Color fundus photograph.
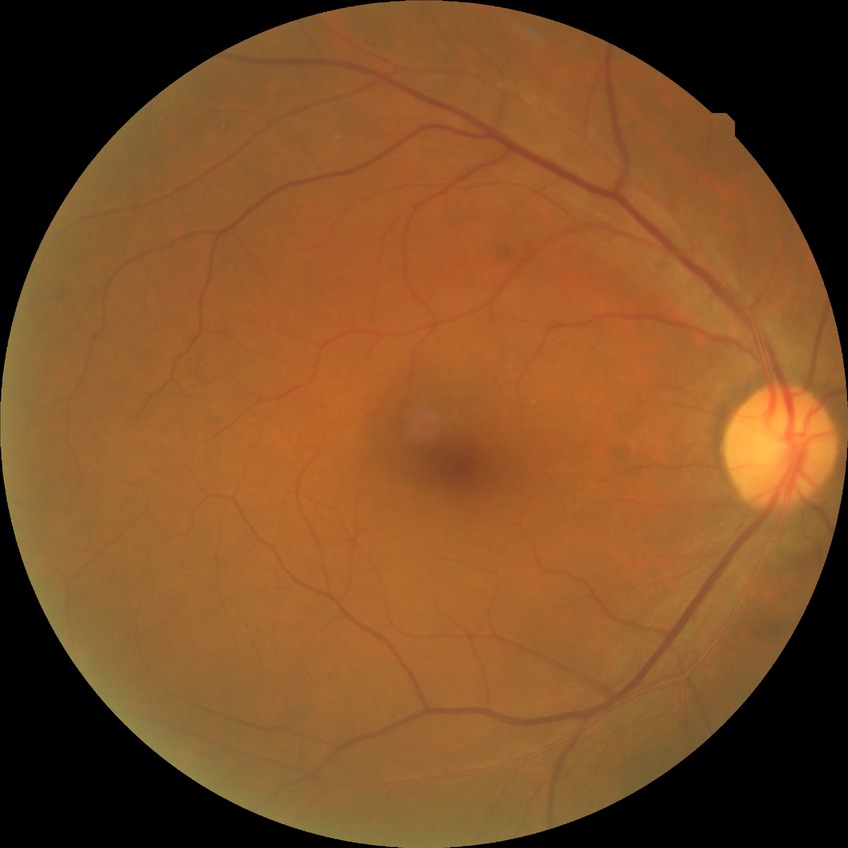 {
  "davis_grade": "no diabetic retinopathy (NDR)"
}